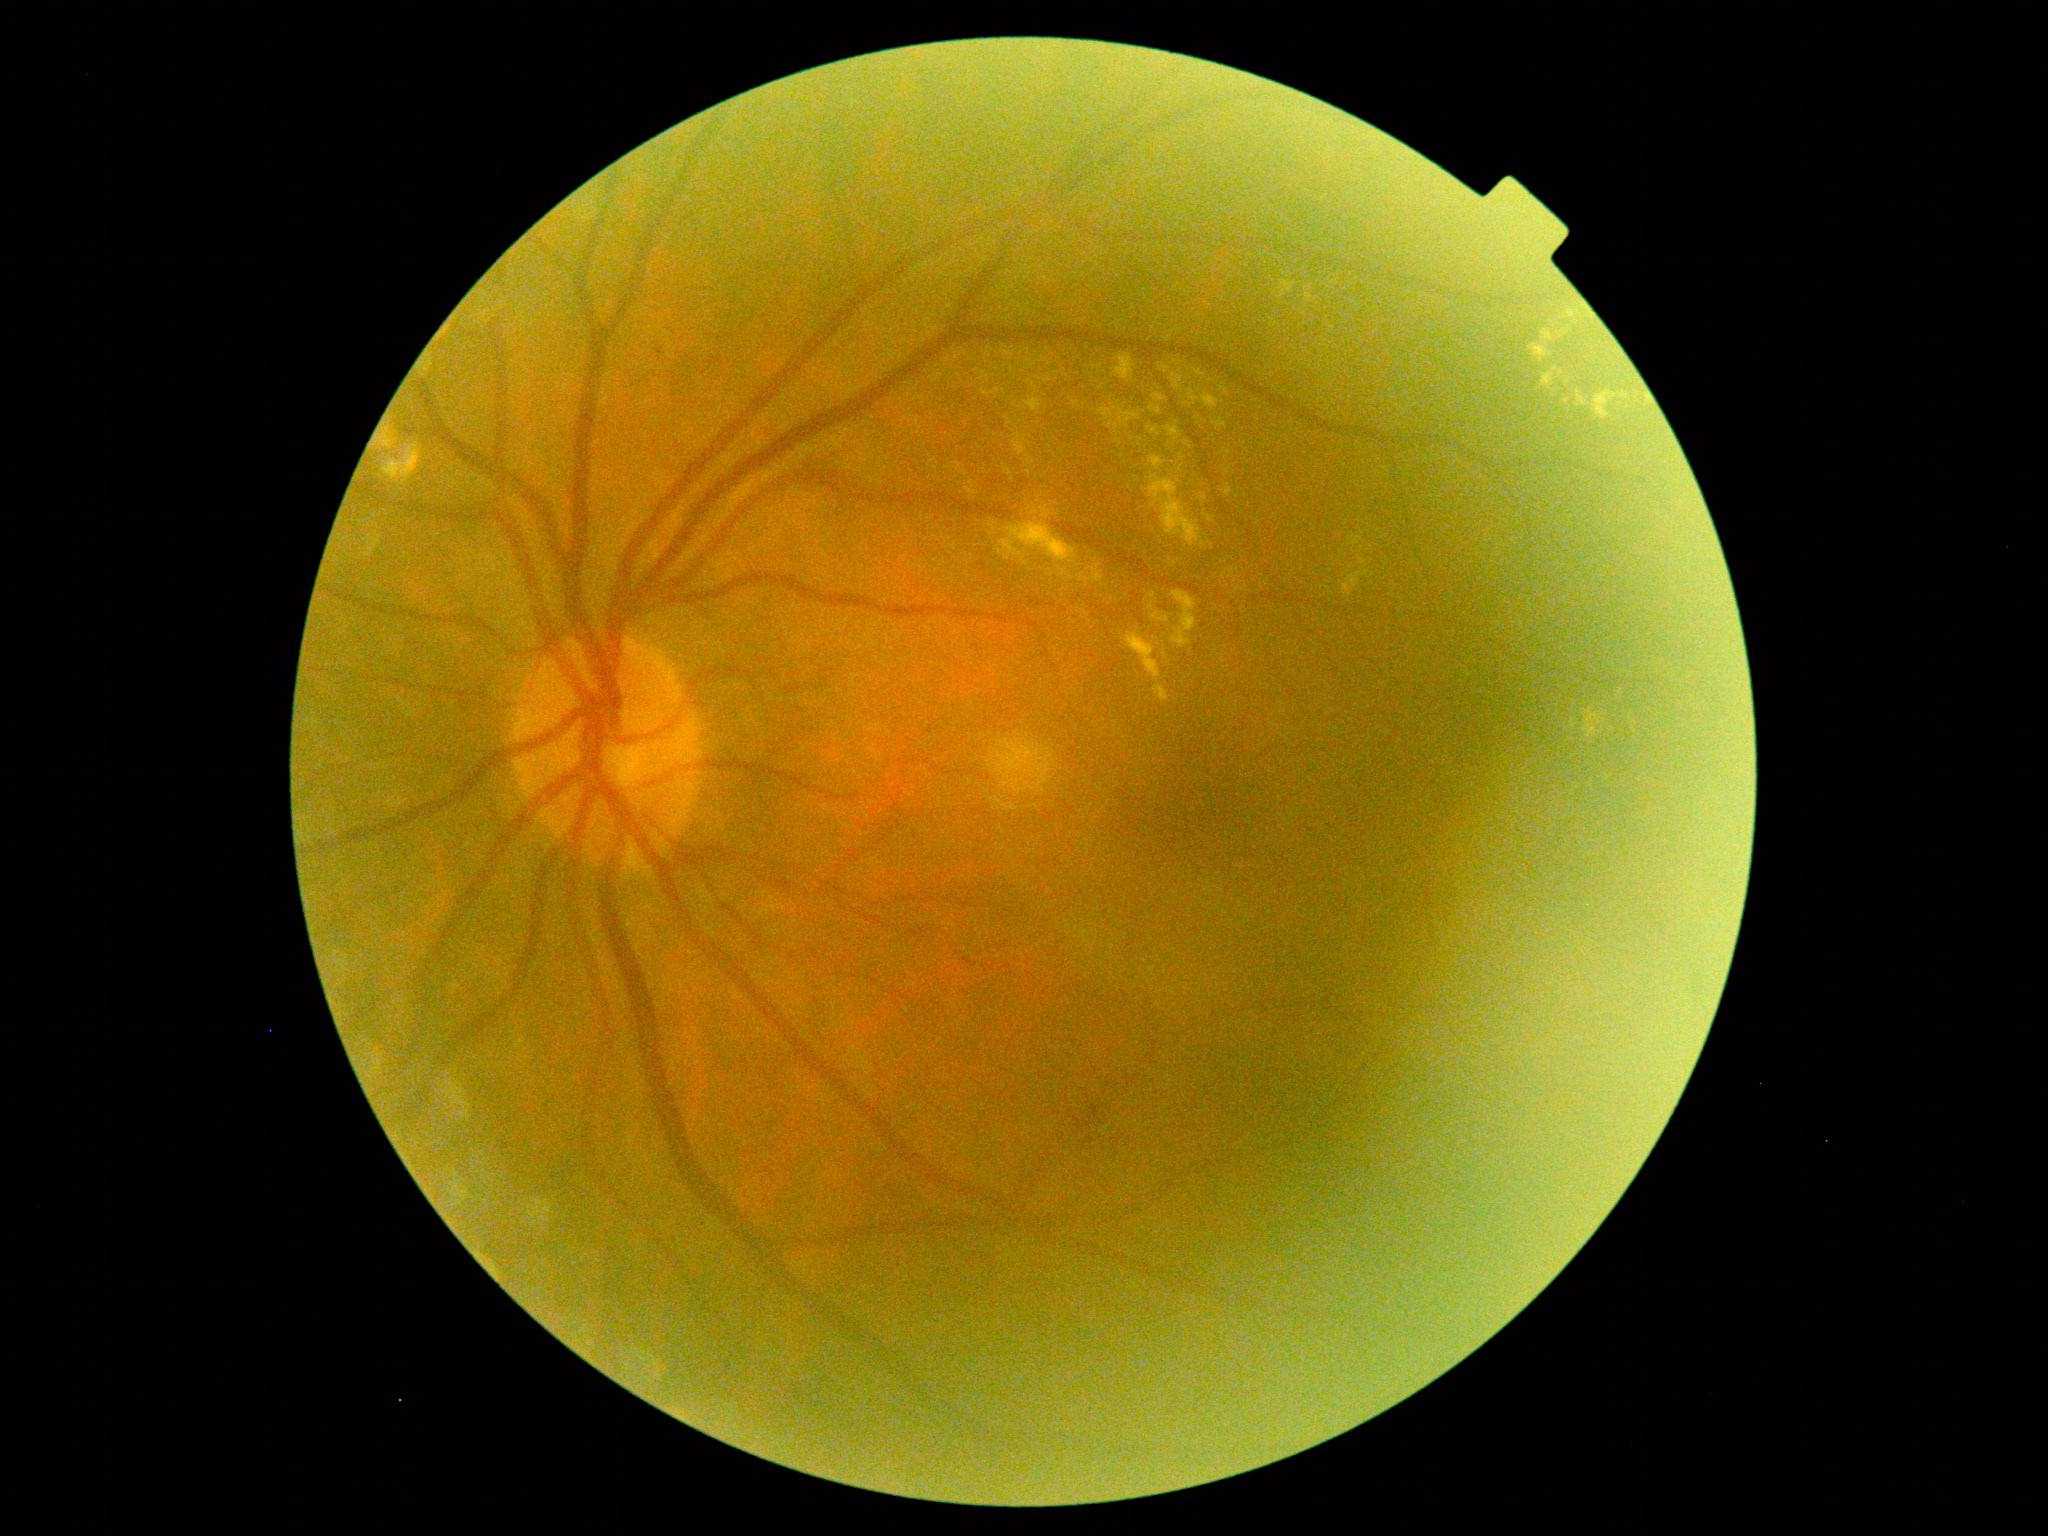 DR is grade 2 (moderate NPDR) — more than just microaneurysms but less than severe NPDR.